Wide-field fundus photograph from neonatal ROP screening:
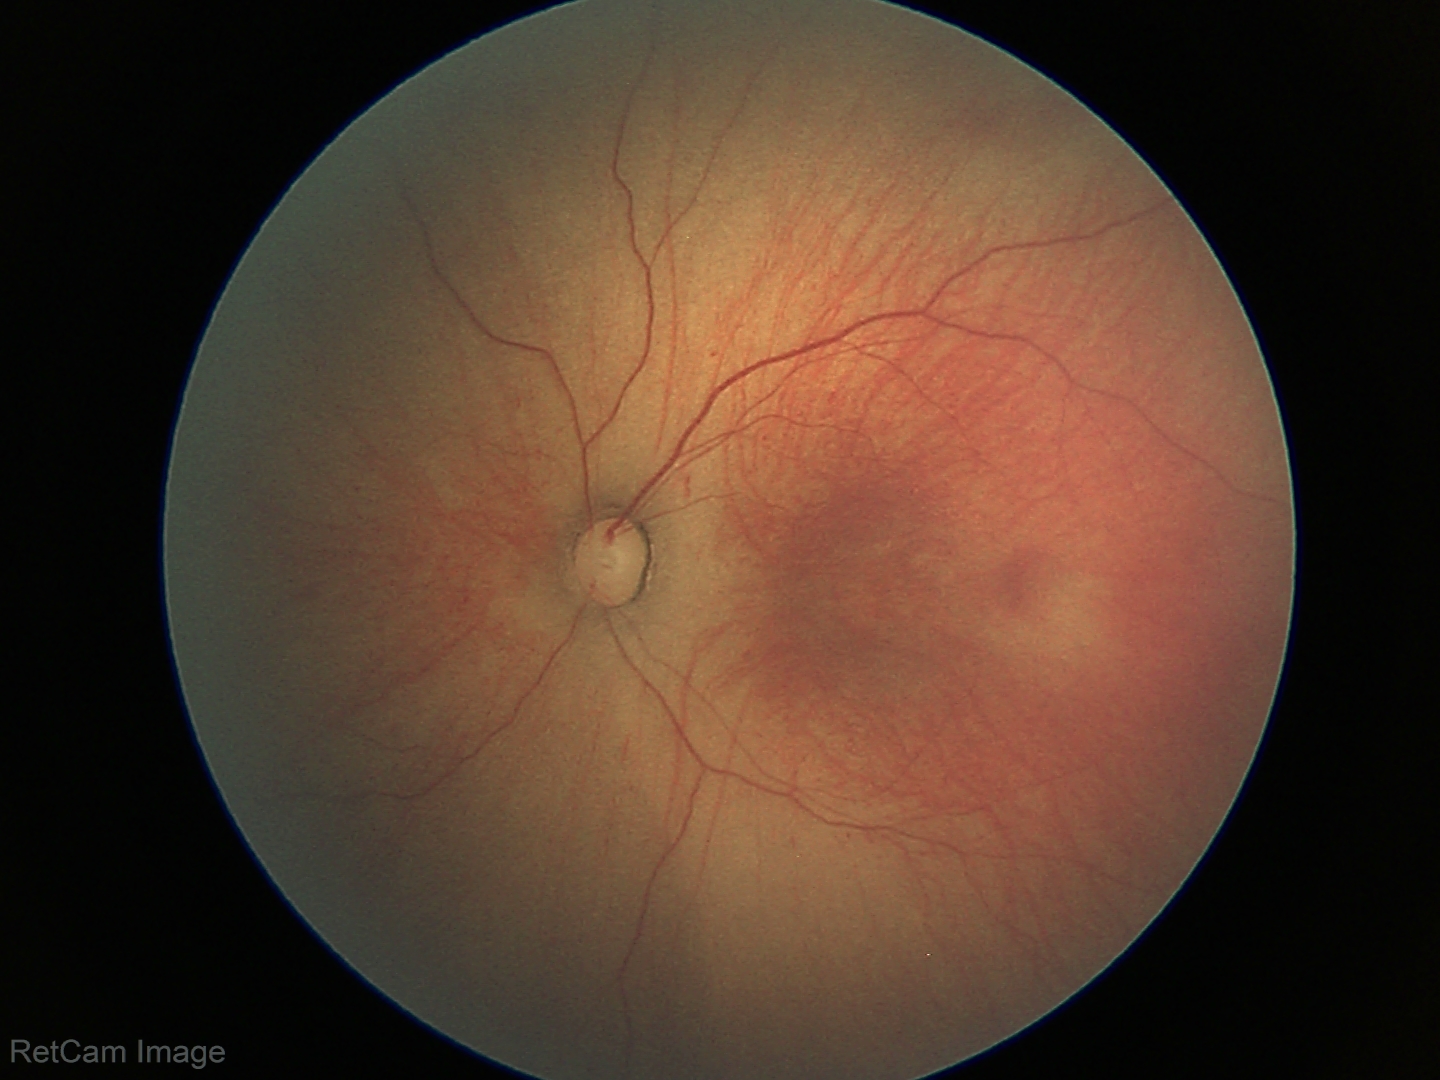

Assessment: no plus disease; ROP stage 1 — demarcation line between vascular and avascular retina.